2346x1568:
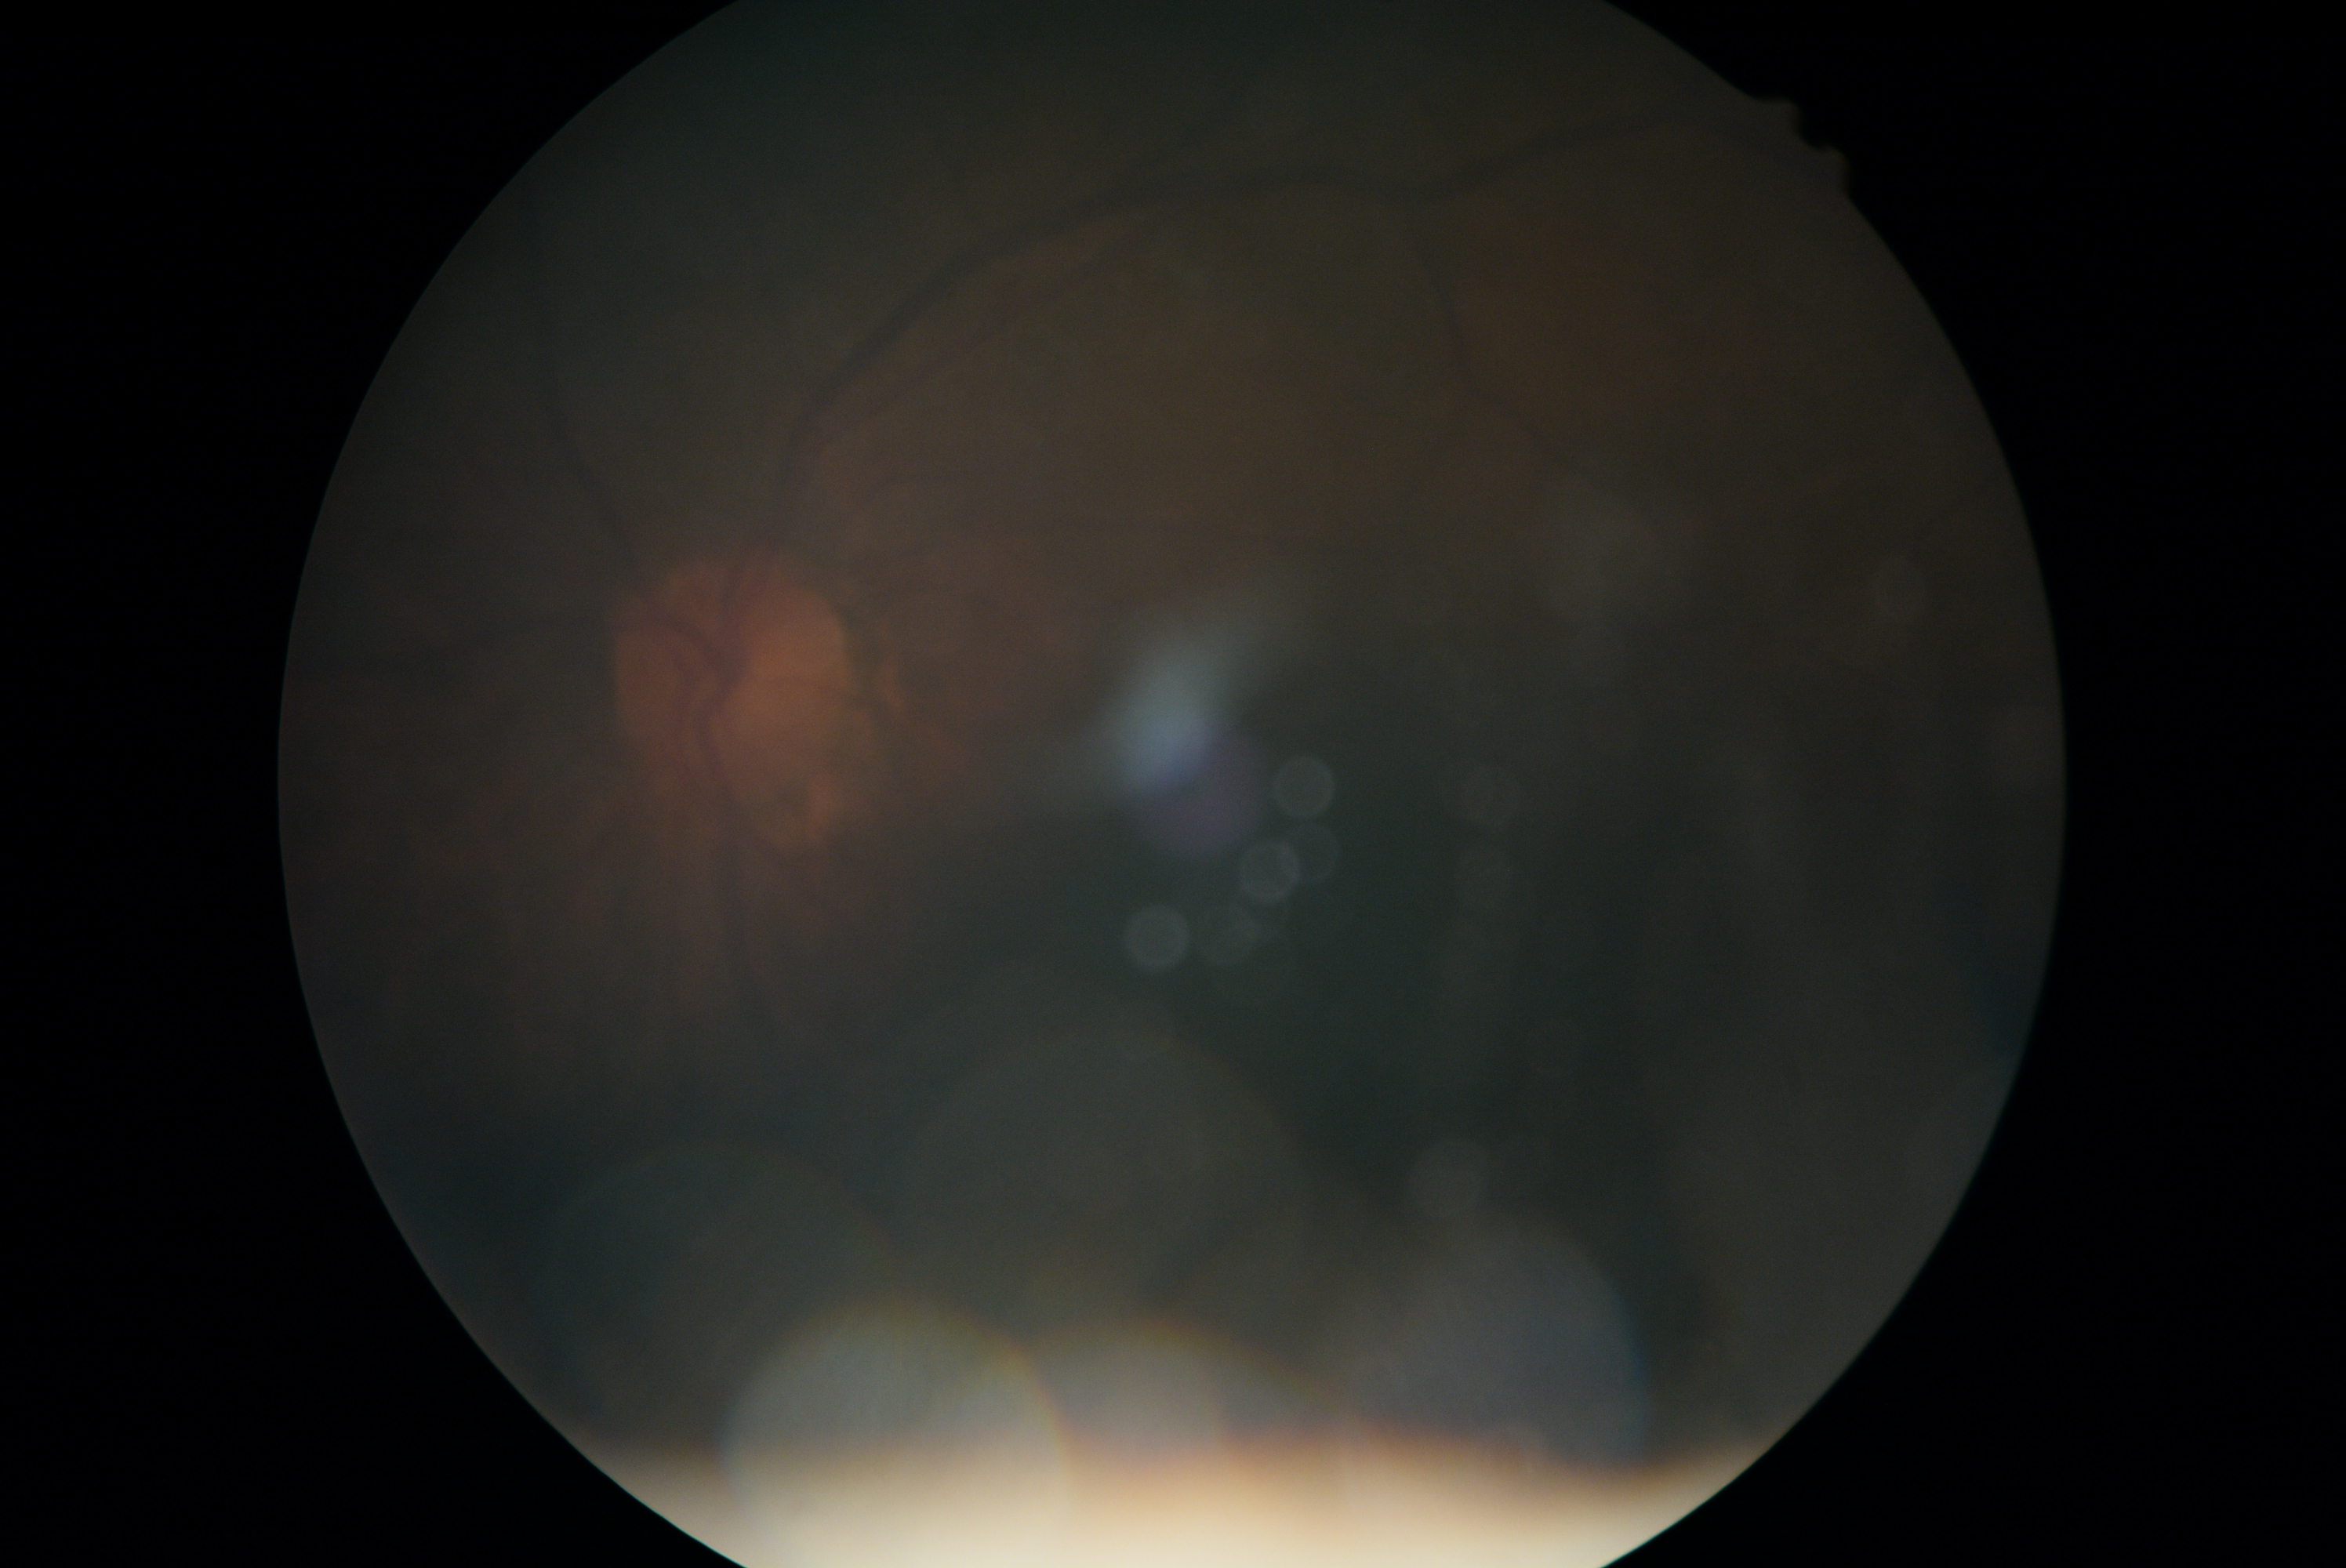
Retinopathy grade: ungradable.
Ungradable image — DR severity cannot be determined.